45° field of view, 2352 x 1568 pixels, retinal fundus photograph — 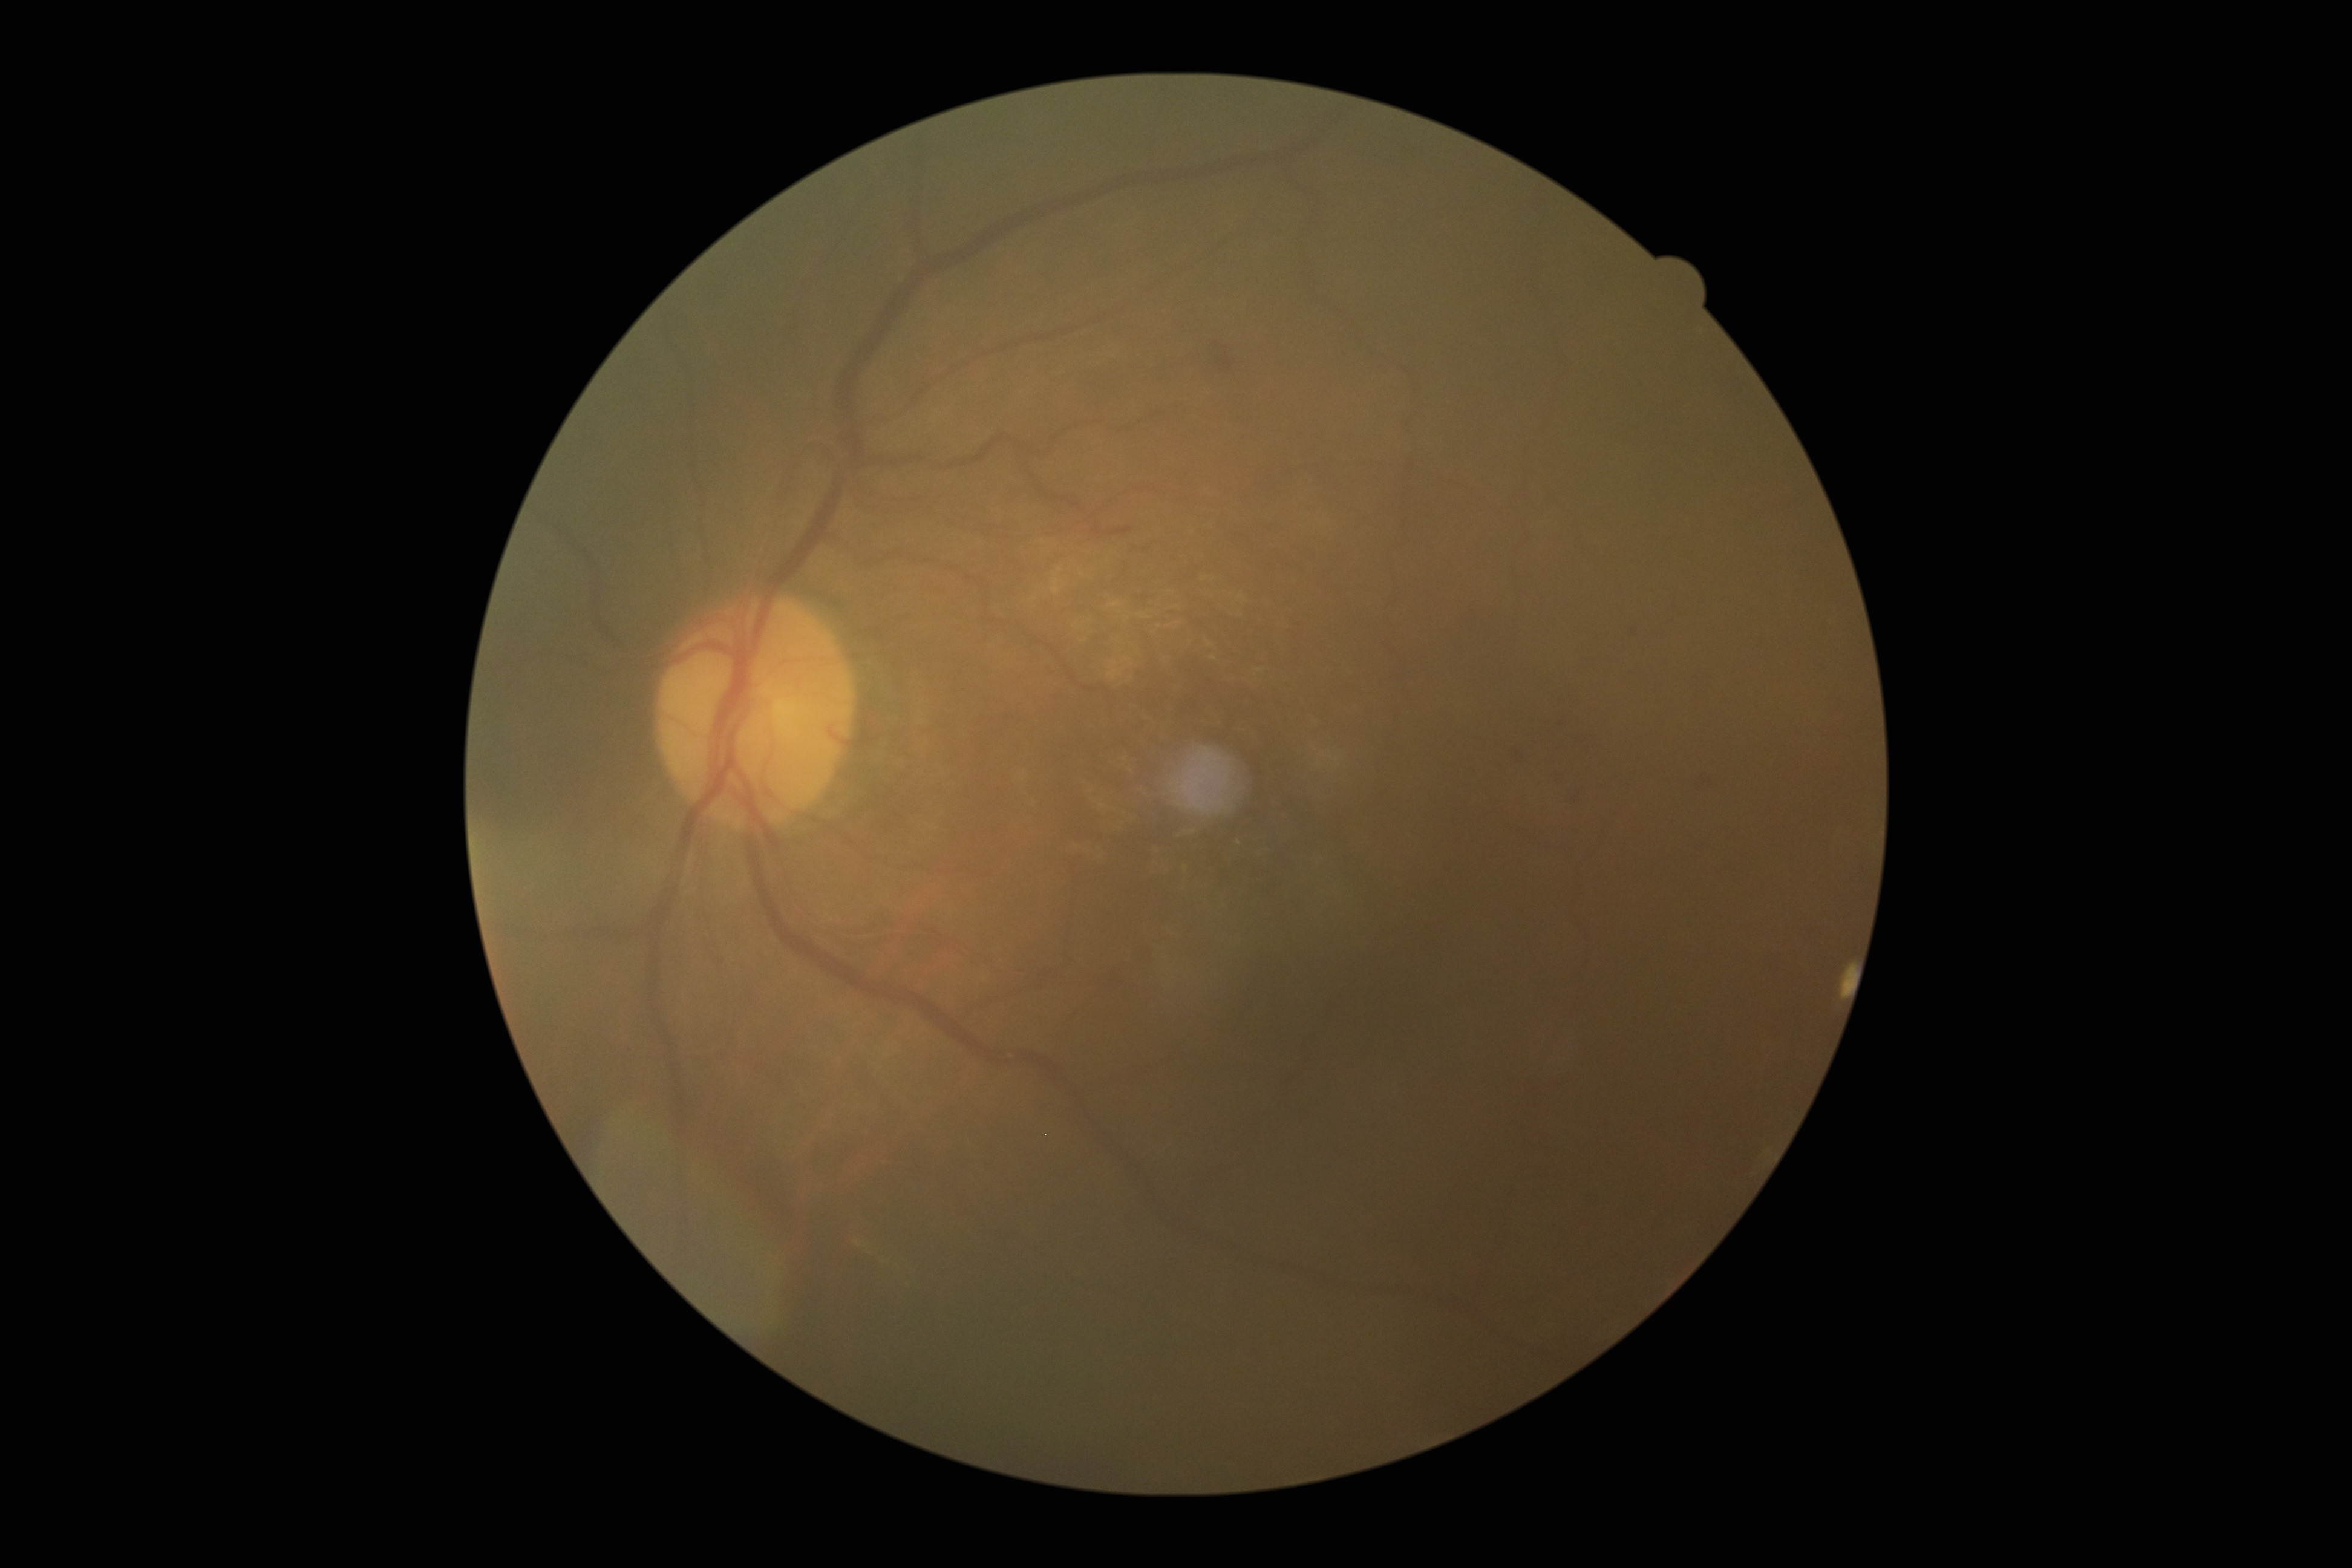 DR stage: 2.